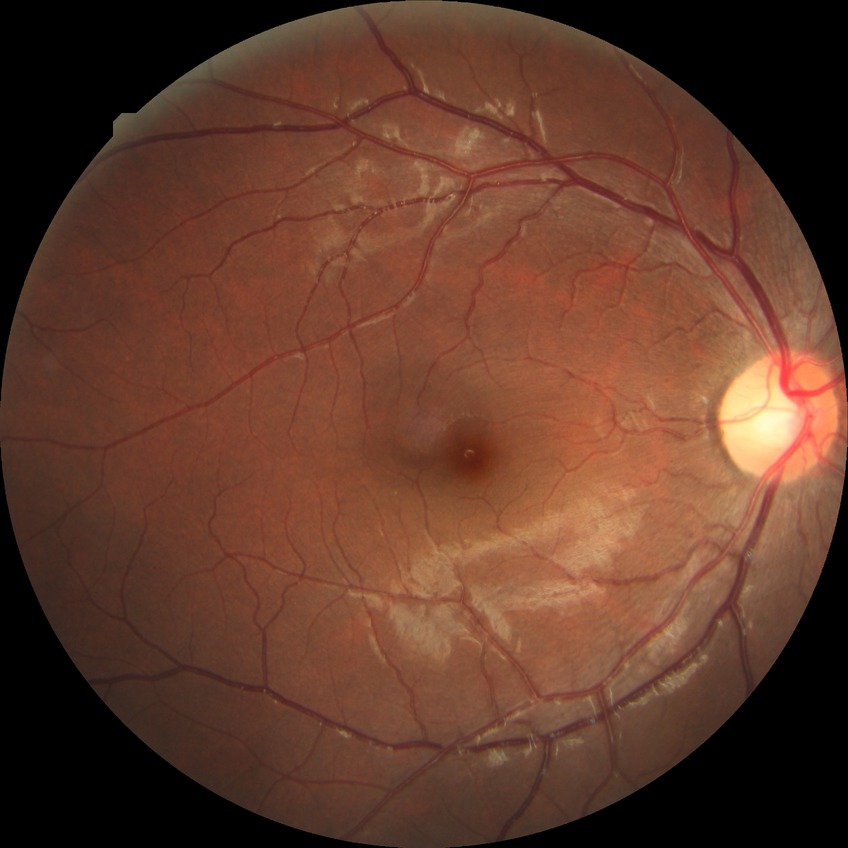 Diabetic retinopathy severity: no diabetic retinopathy.